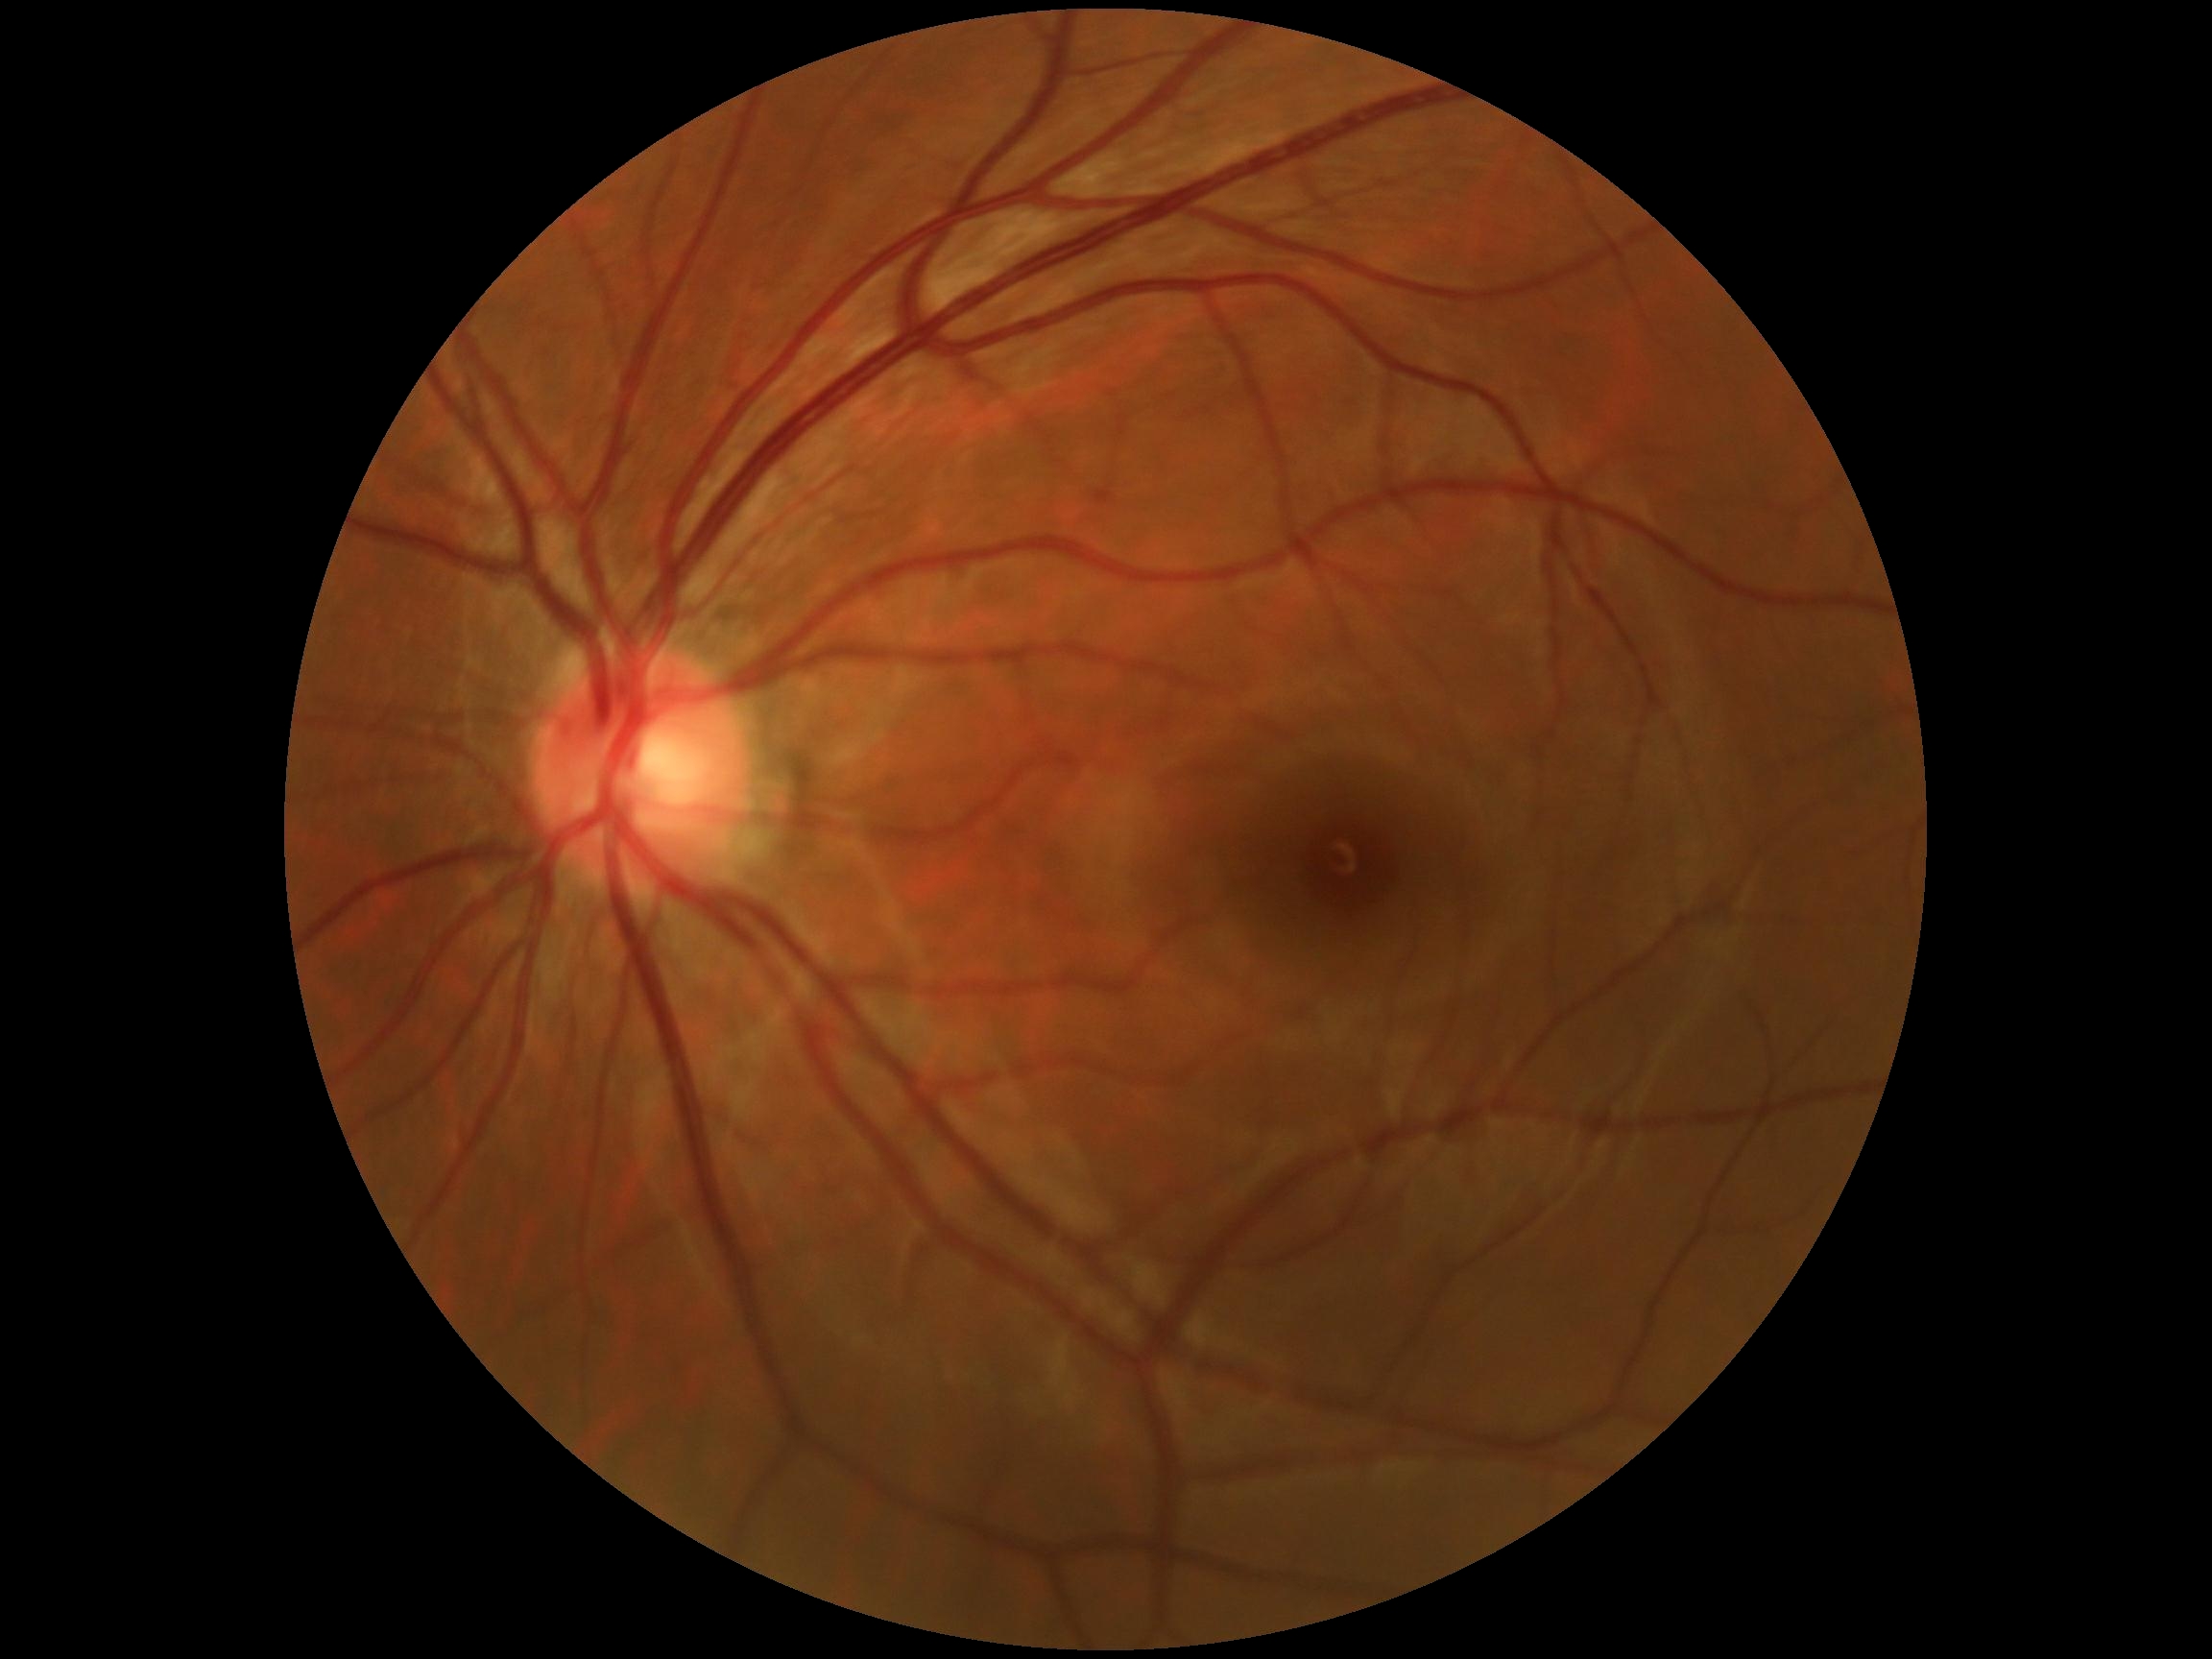 DR stage: grade 0 (no apparent retinopathy).